Wide-field fundus photograph of an infant:
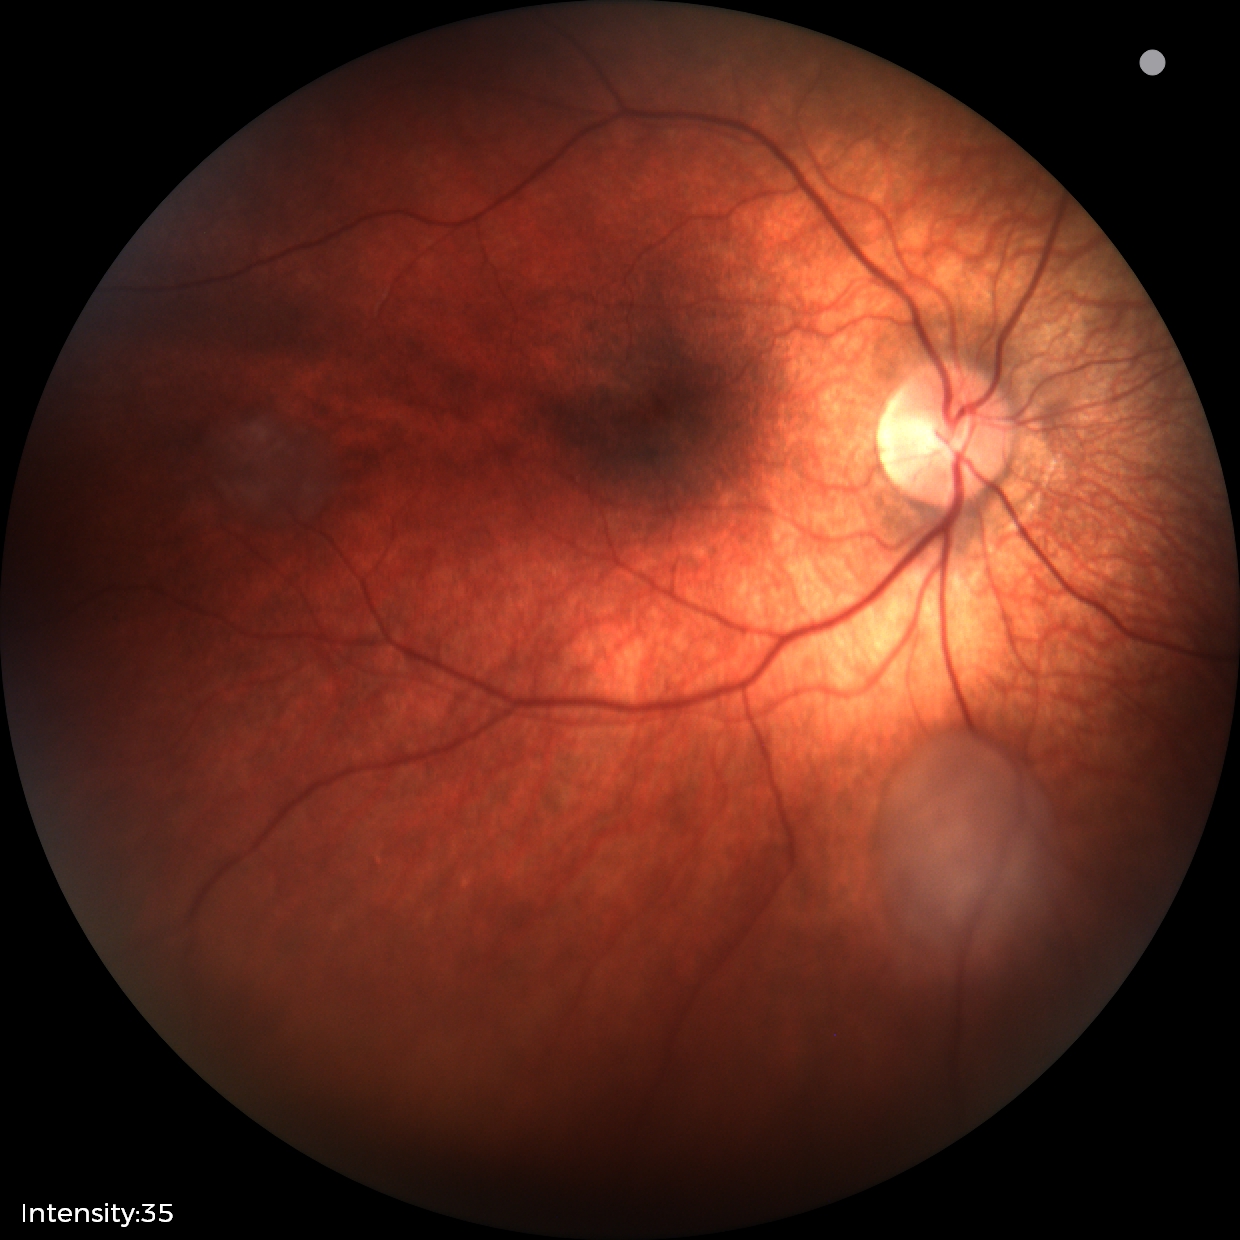 Examination diagnosed as retinal astrocytic hamartoma.